Color fundus photograph, 2352 by 1568 pixels — 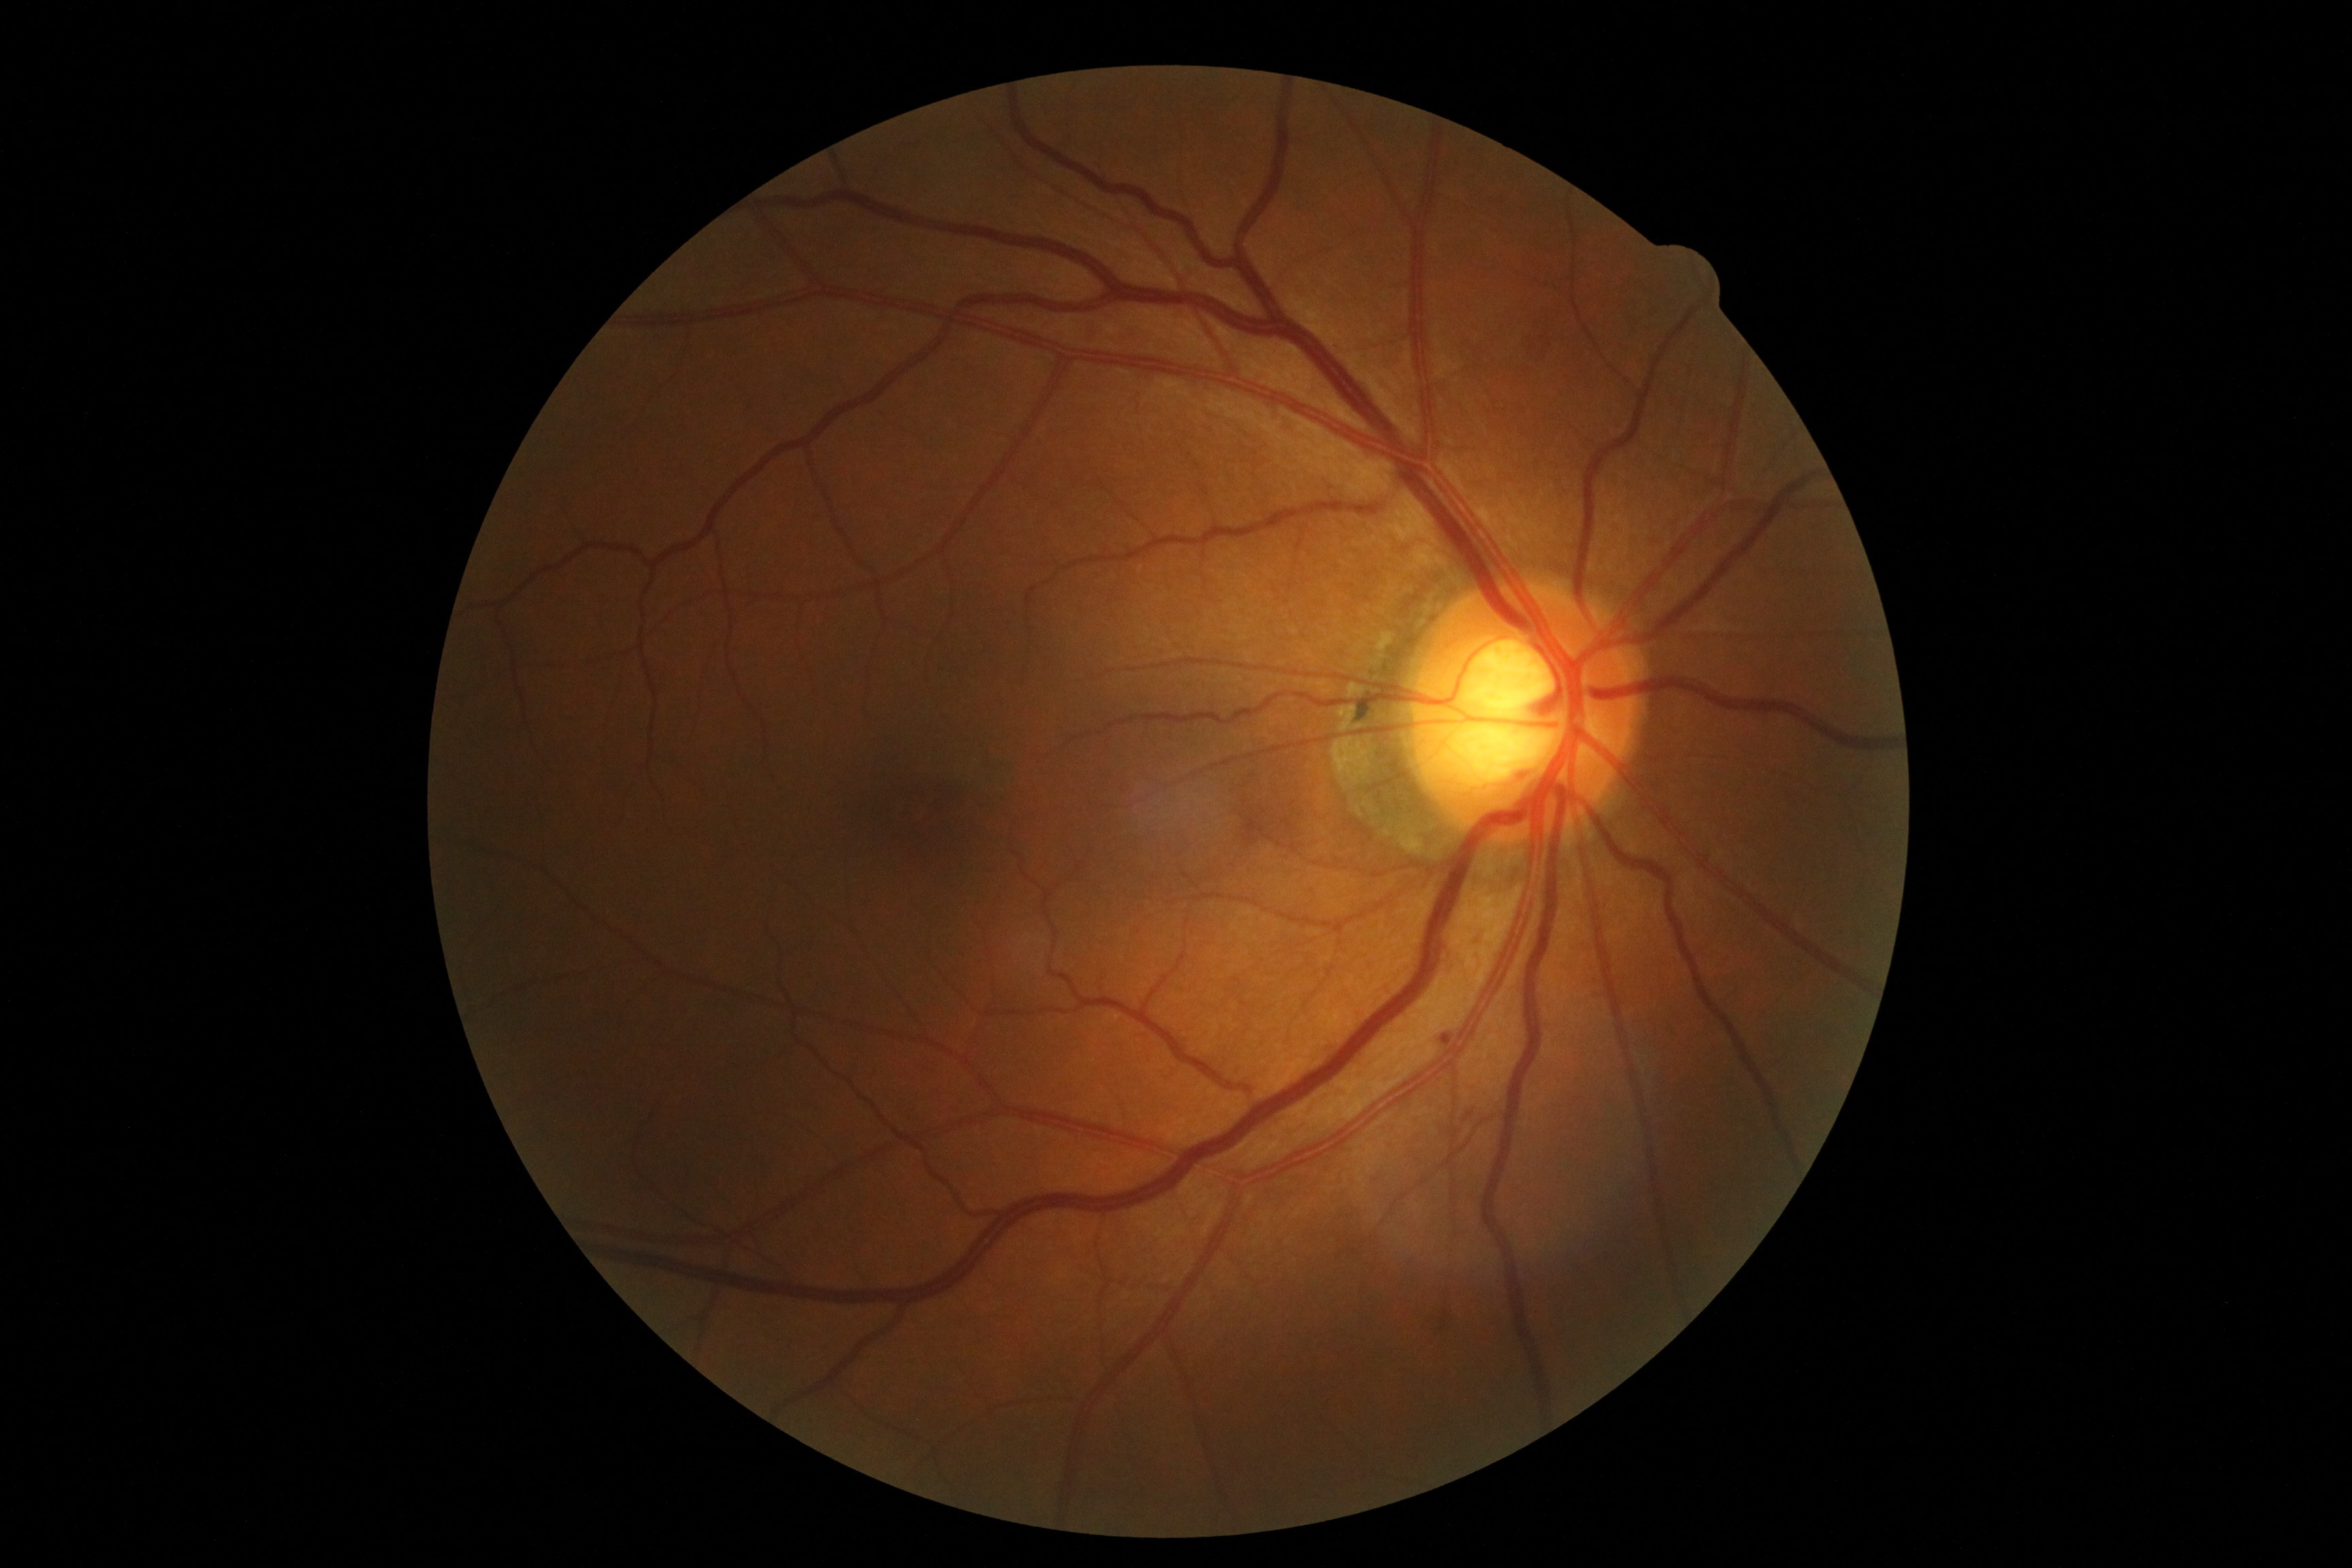

DR stage: grade 1 — presence of microaneurysms only
EXs: none
MAs: BBox(1442, 1035, 1453, 1045)
HEs: none
SEs: none